Remidio Fundus on Phone. CFP
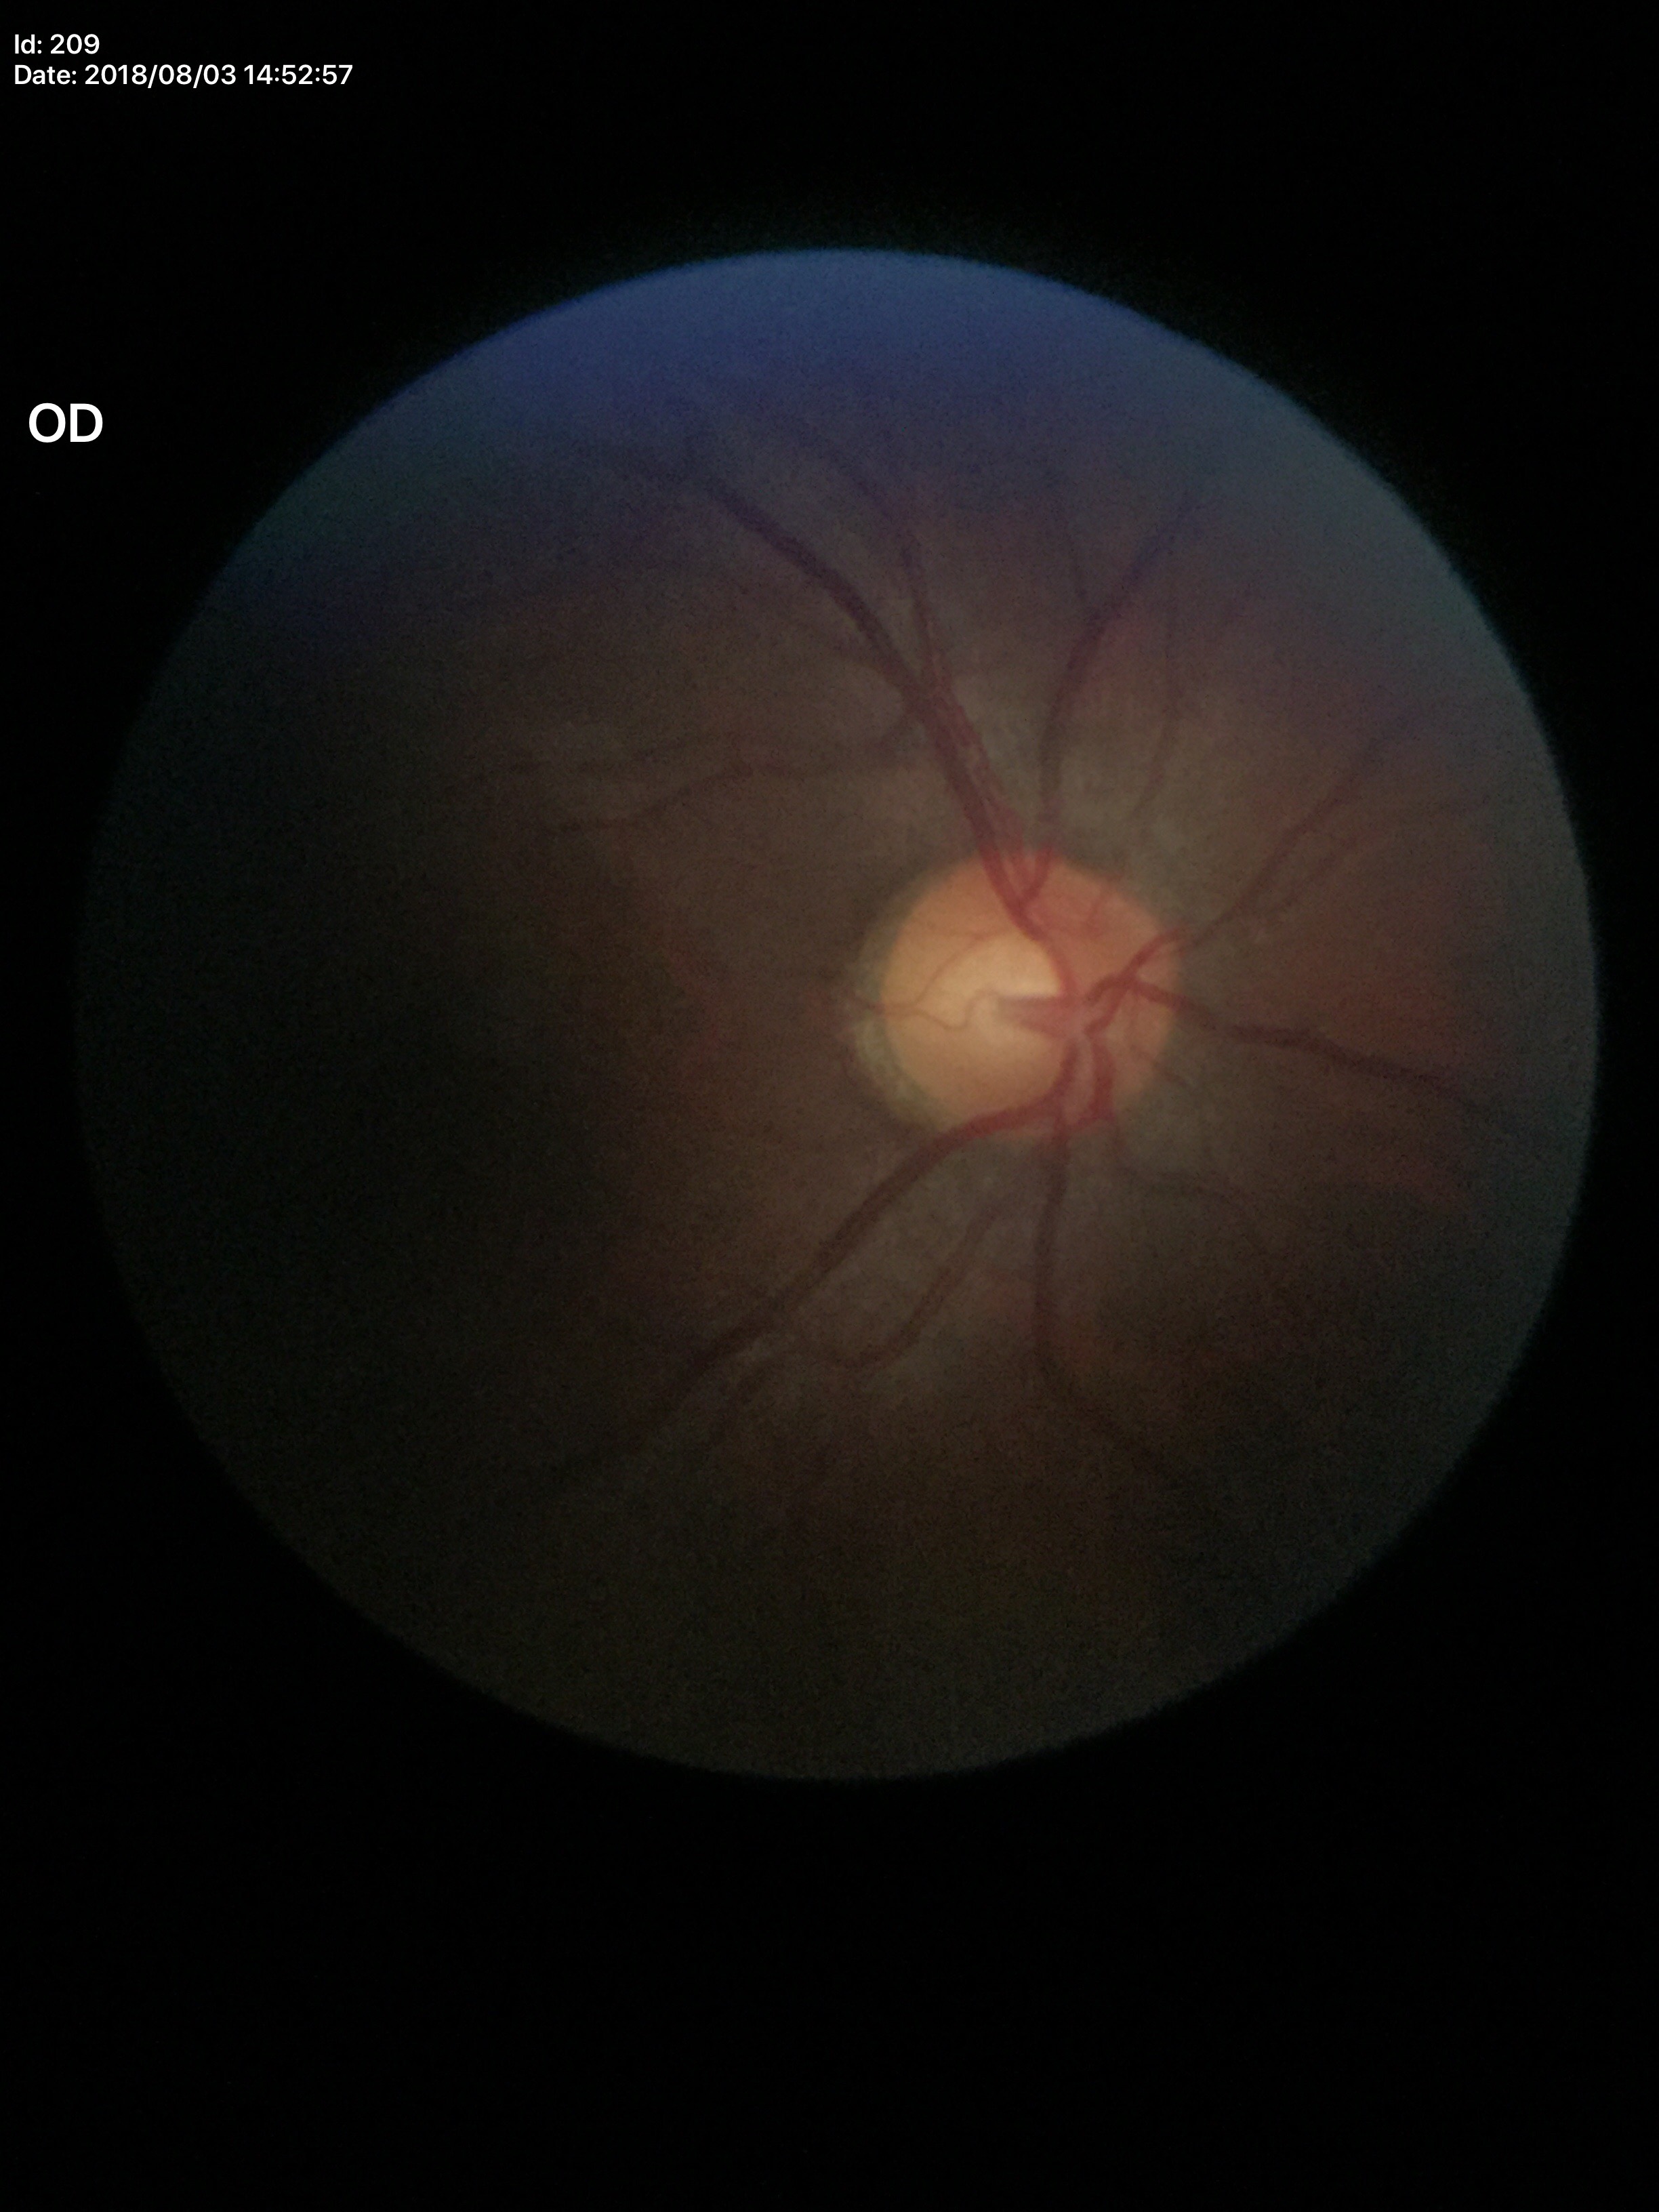 Not suspicious for glaucoma. Horizontal cup-to-disc ratio of 0.54. Vertical CDR is 0.54.